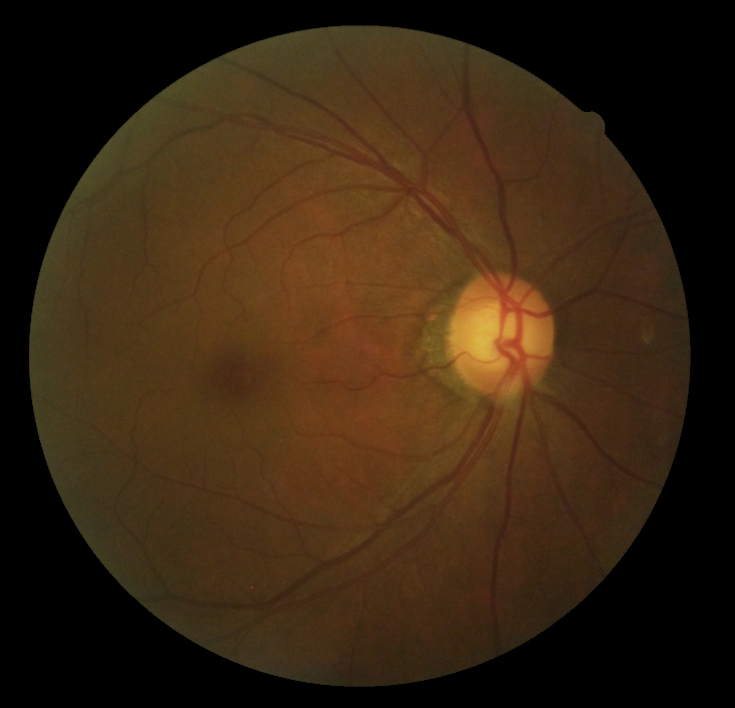 DR stage: grade 0.